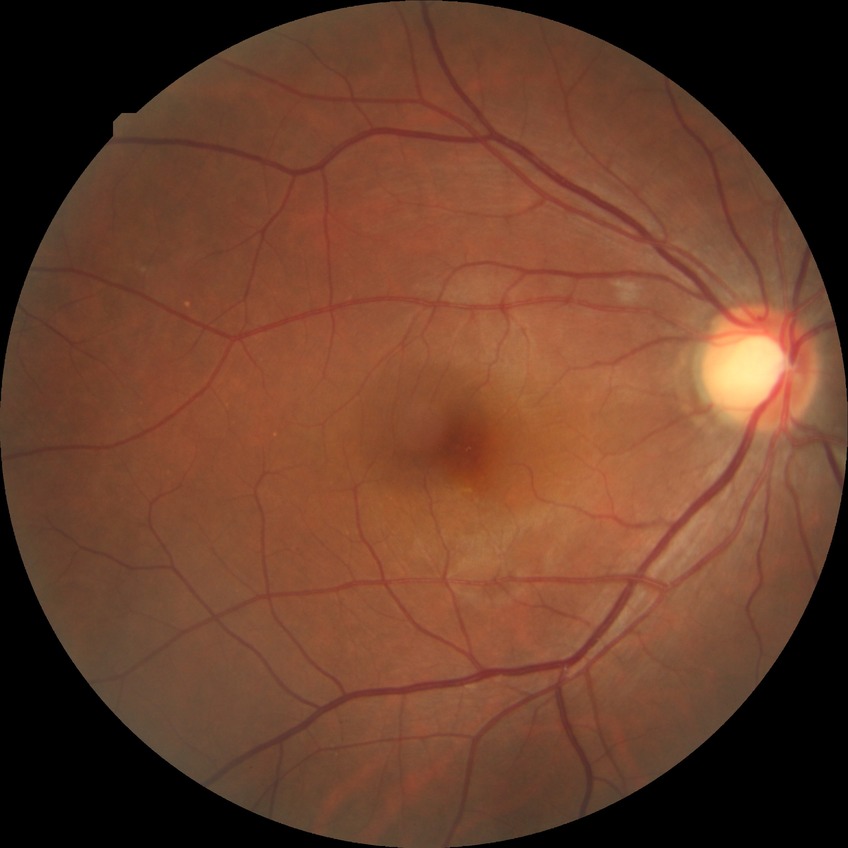
DR impression@no apparent DR, modified Davis grade@NDR.